1440x1080px; wide-field fundus photograph from neonatal ROP screening: 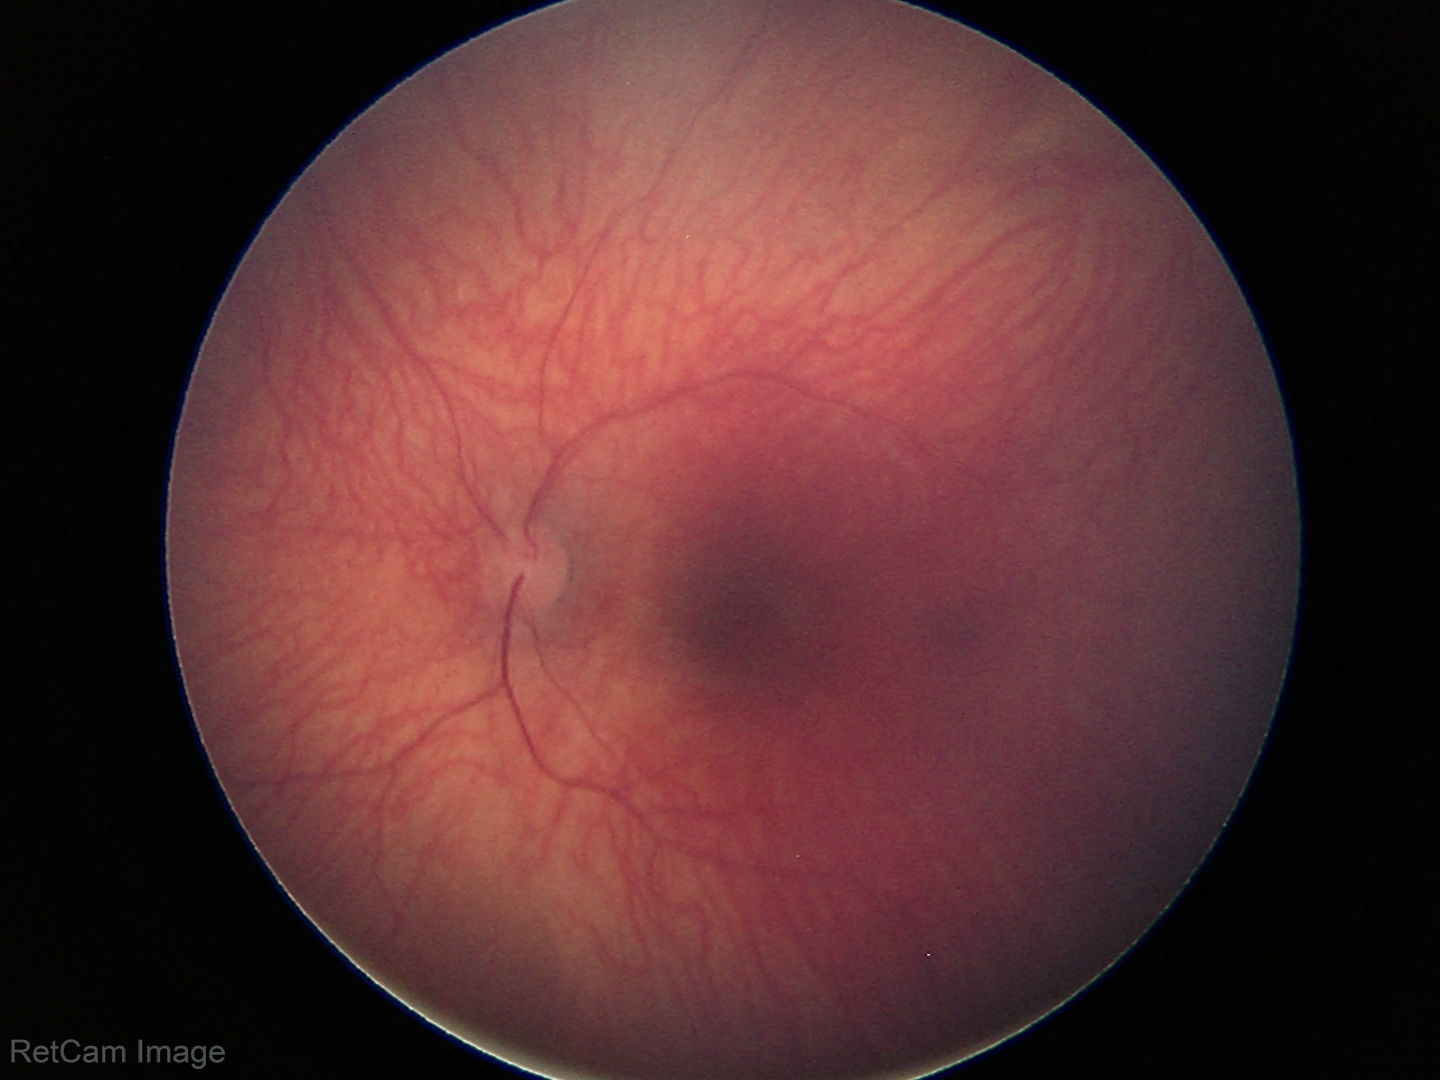
Examination with physiological retinal findings.